1932x1932px: 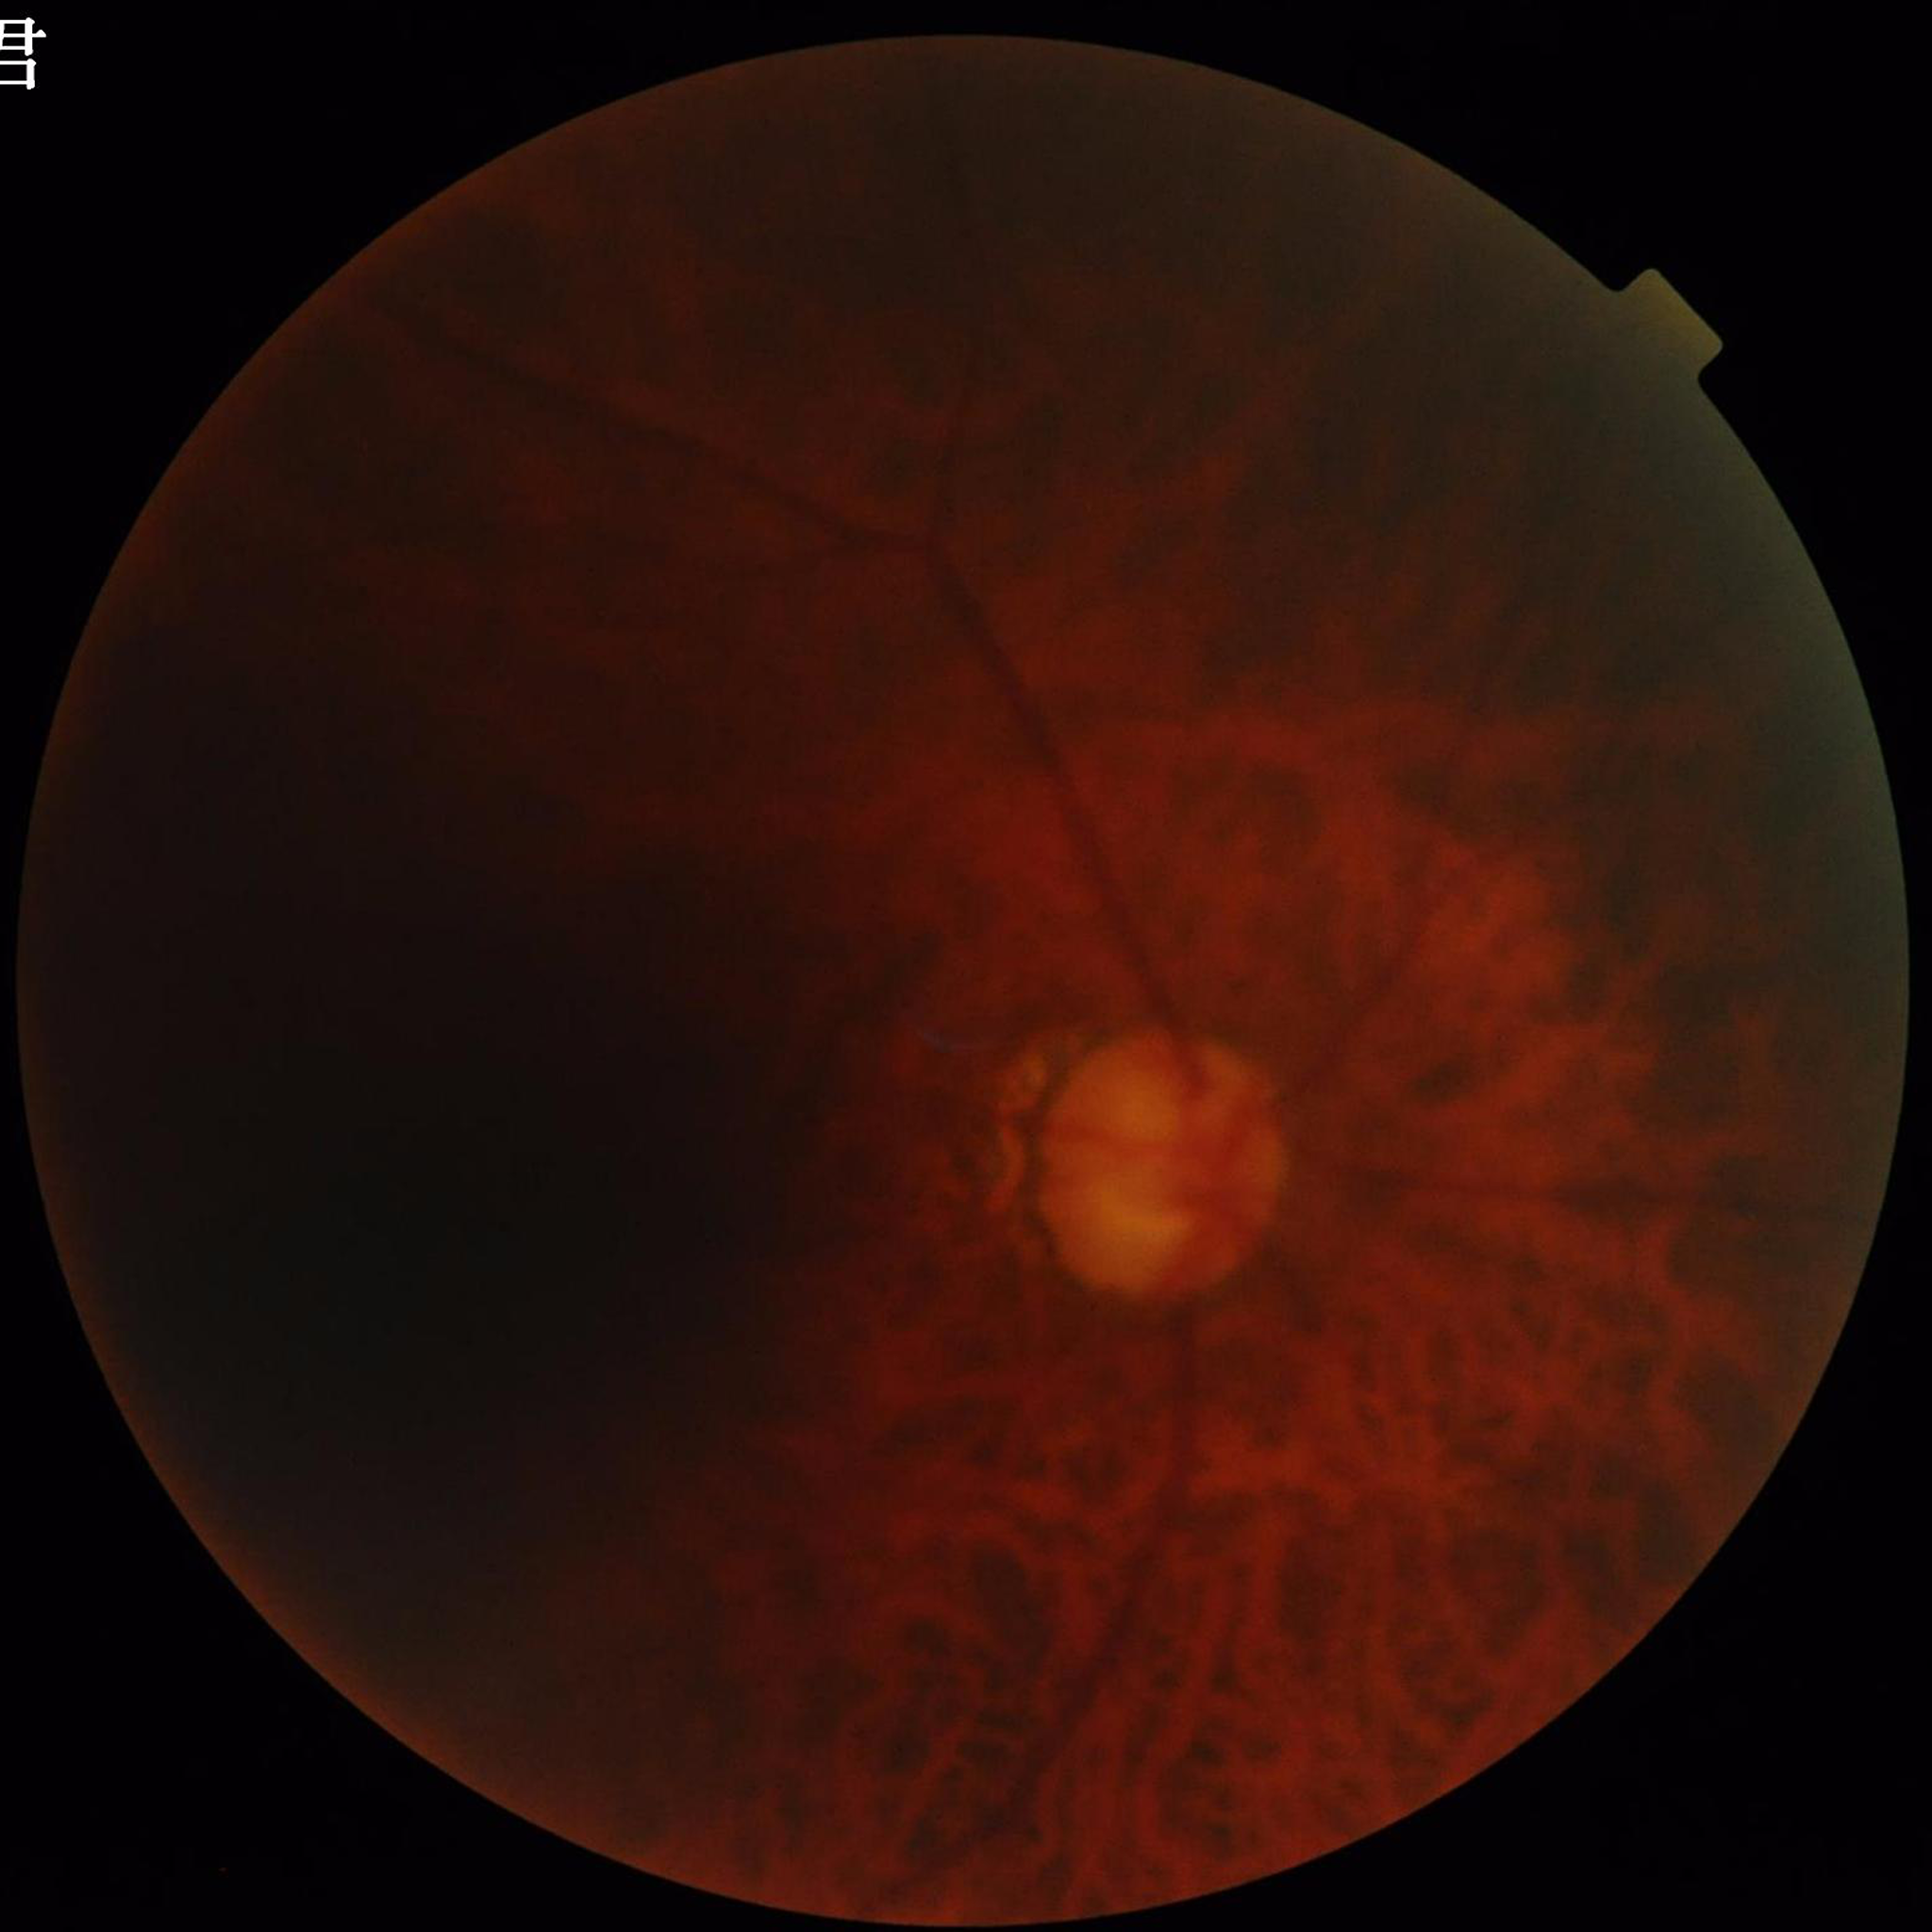 Photo quality: blur present, illumination/color distortion present, low contrast
Disease class: glaucoma